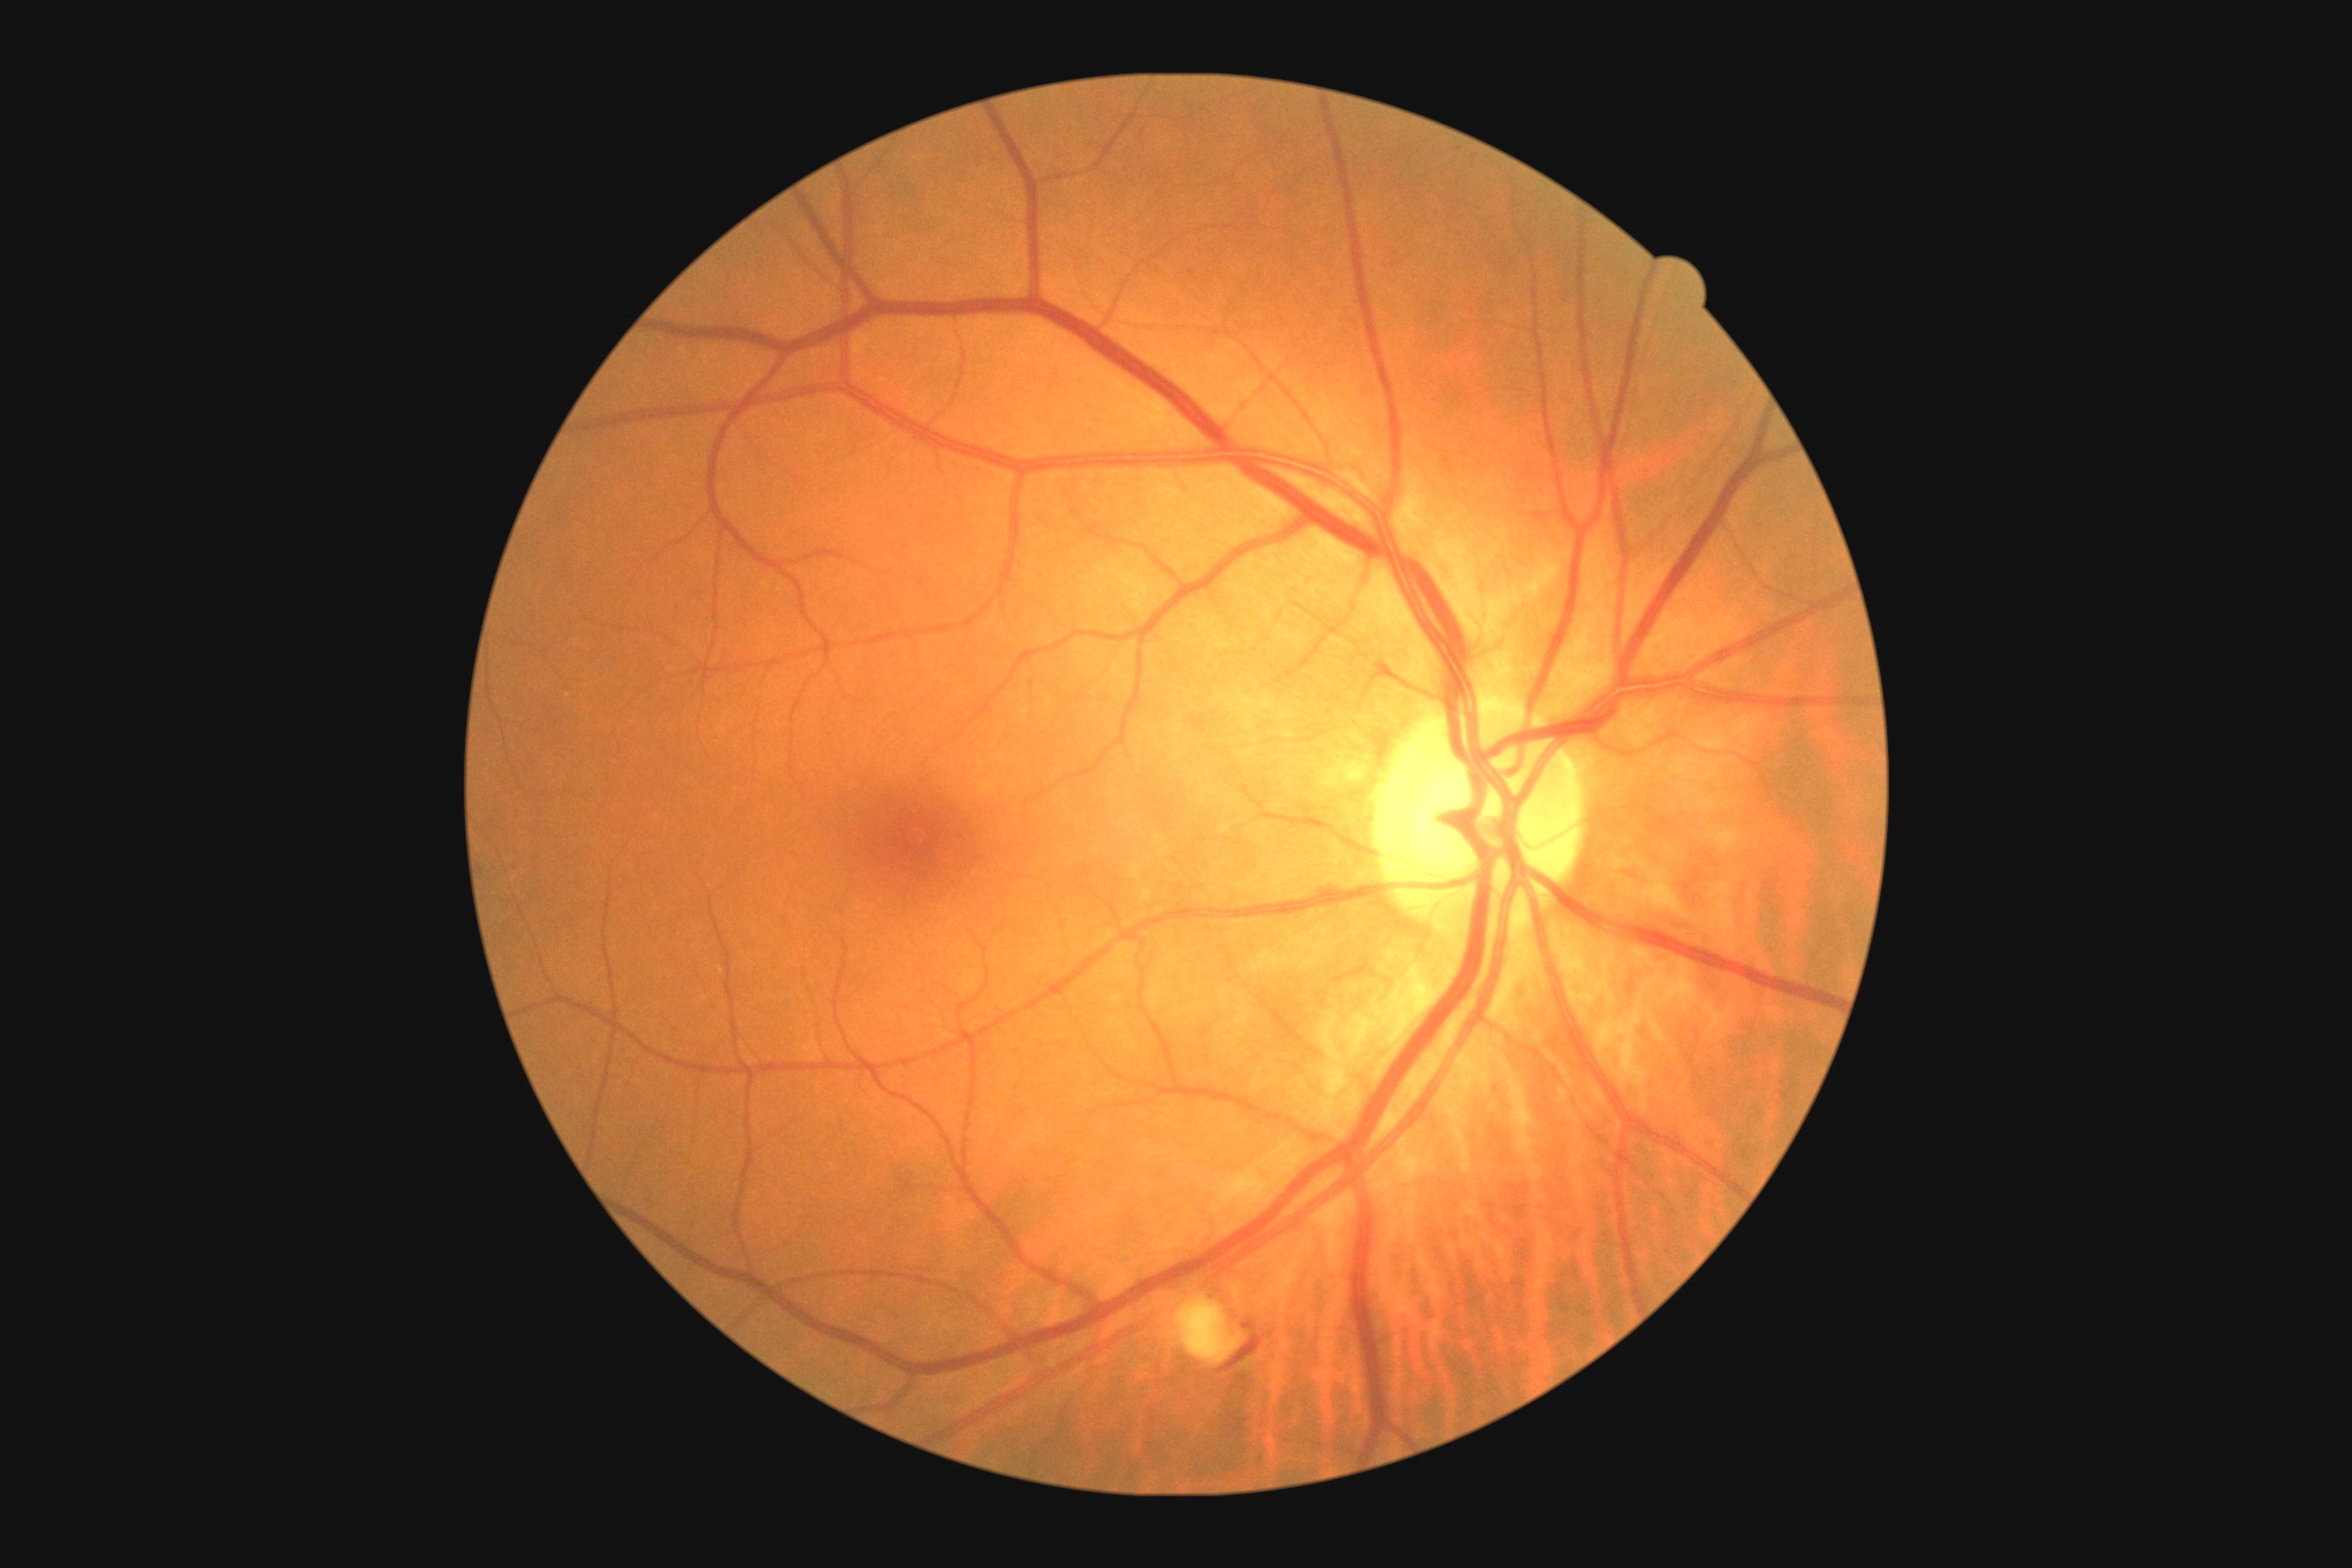 DR severity: grade 2
Findings:
- EXs: none detected
- HEs: 1220/1335/1262/1373
- SEs: 1175/1297/1244/1366
- MAs: 1242/1320/1255/1331